848 by 848 pixels; nonmydriatic.
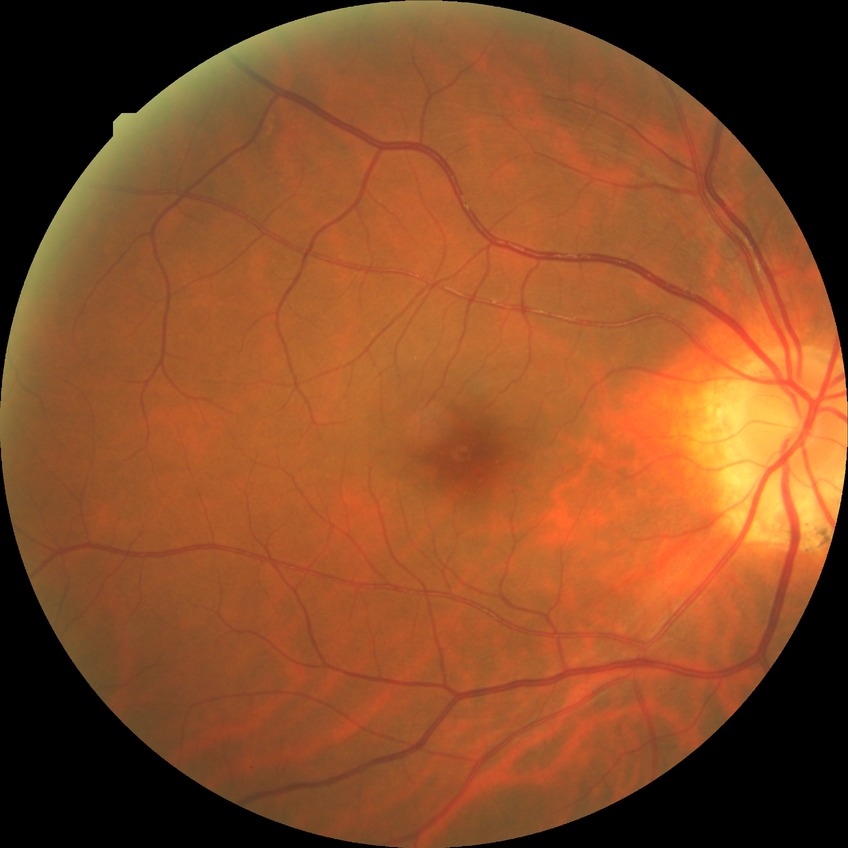

Diabetic retinopathy (DR): no diabetic retinopathy (NDR).